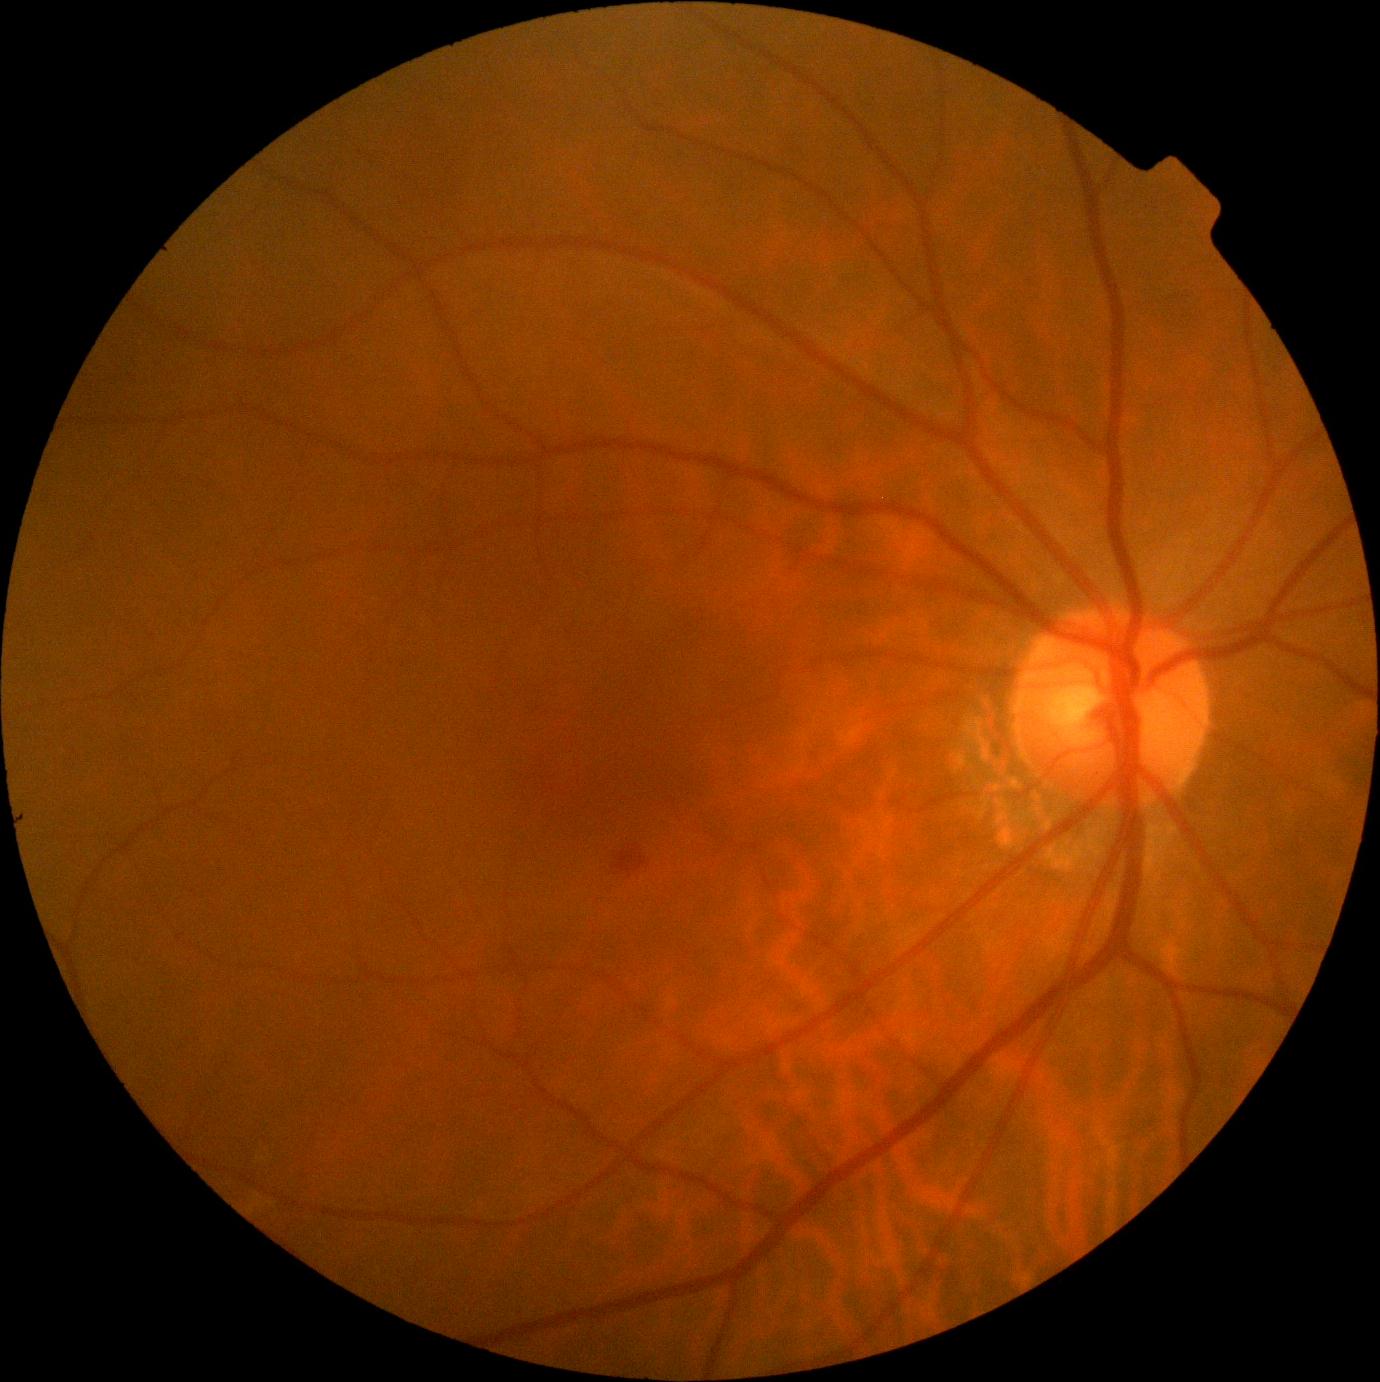
Retinopathy: 2.